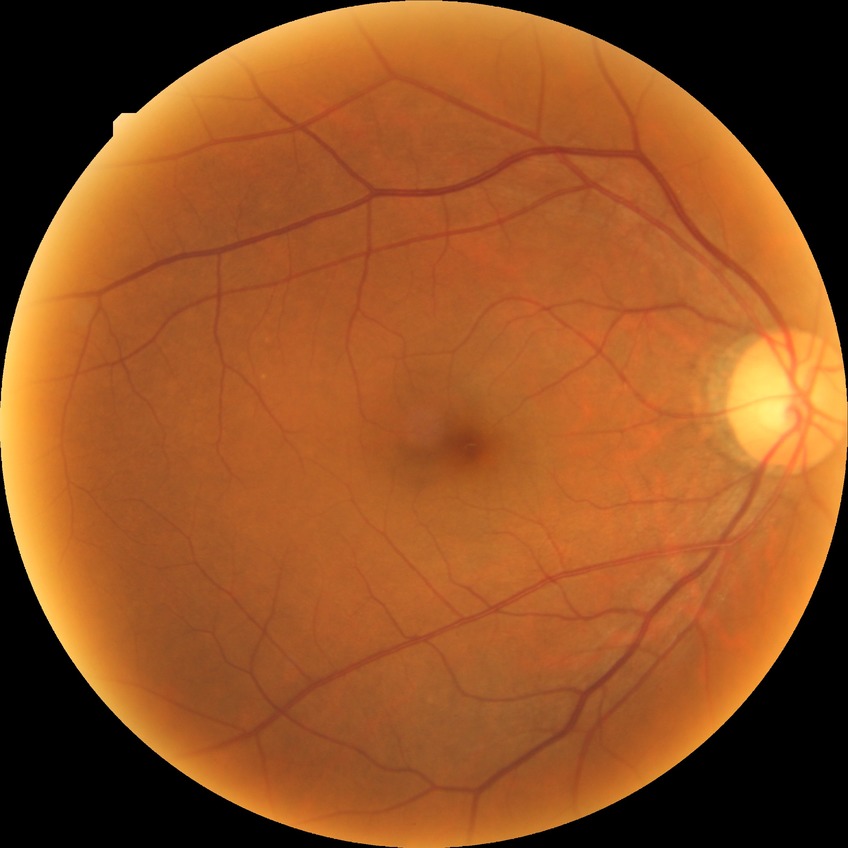
Diabetic retinopathy (DR): NDR (no diabetic retinopathy).